Image size 848x848; 45° FOV; acquired with a NIDEK AFC-230:
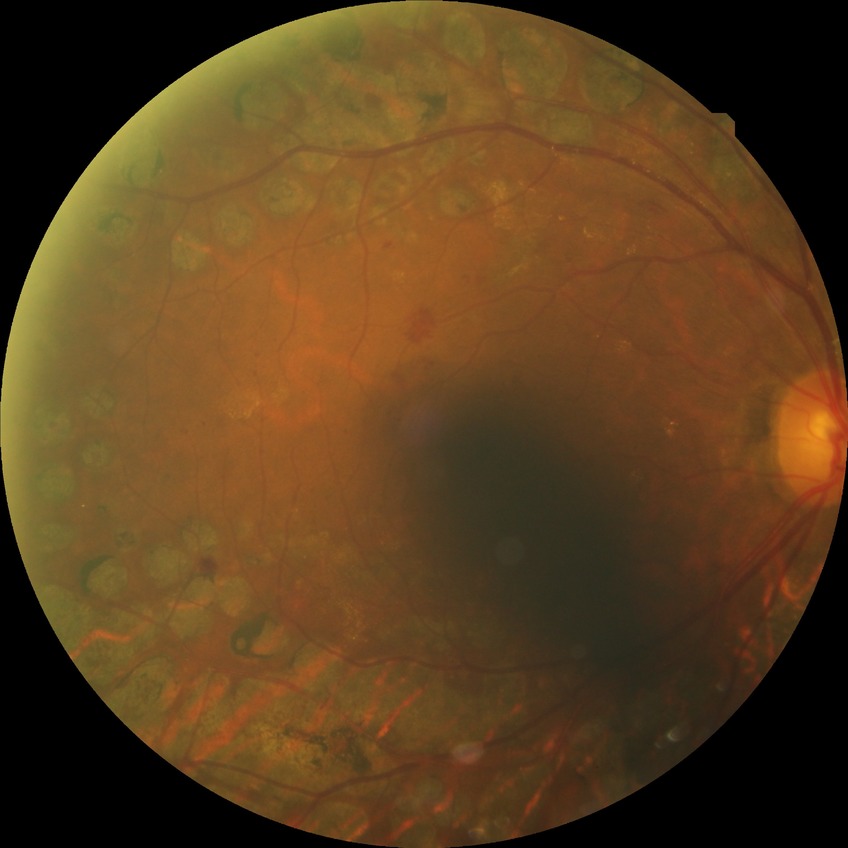
Diabetic retinopathy (DR) is PDR (proliferative diabetic retinopathy).